Diabetic retinopathy graded by the modified Davis classification, camera: NIDEK AFC-230, 45-degree field of view, image size 848x848, nonmydriatic fundus photograph, retinal fundus photograph:
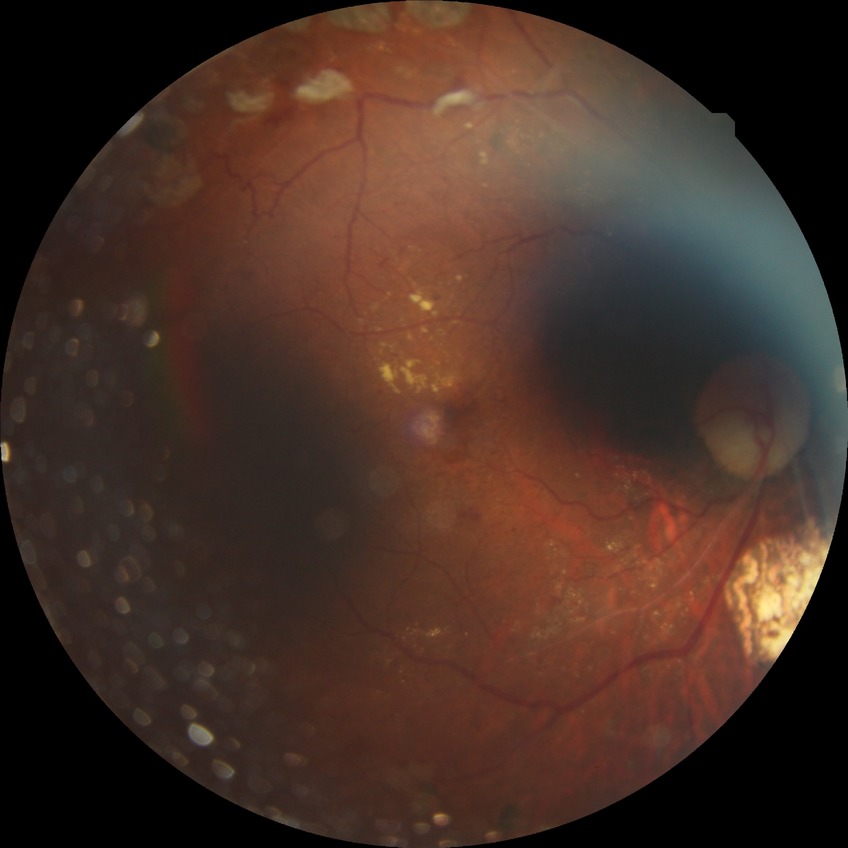
modified Davis grading=proliferative diabetic retinopathy.